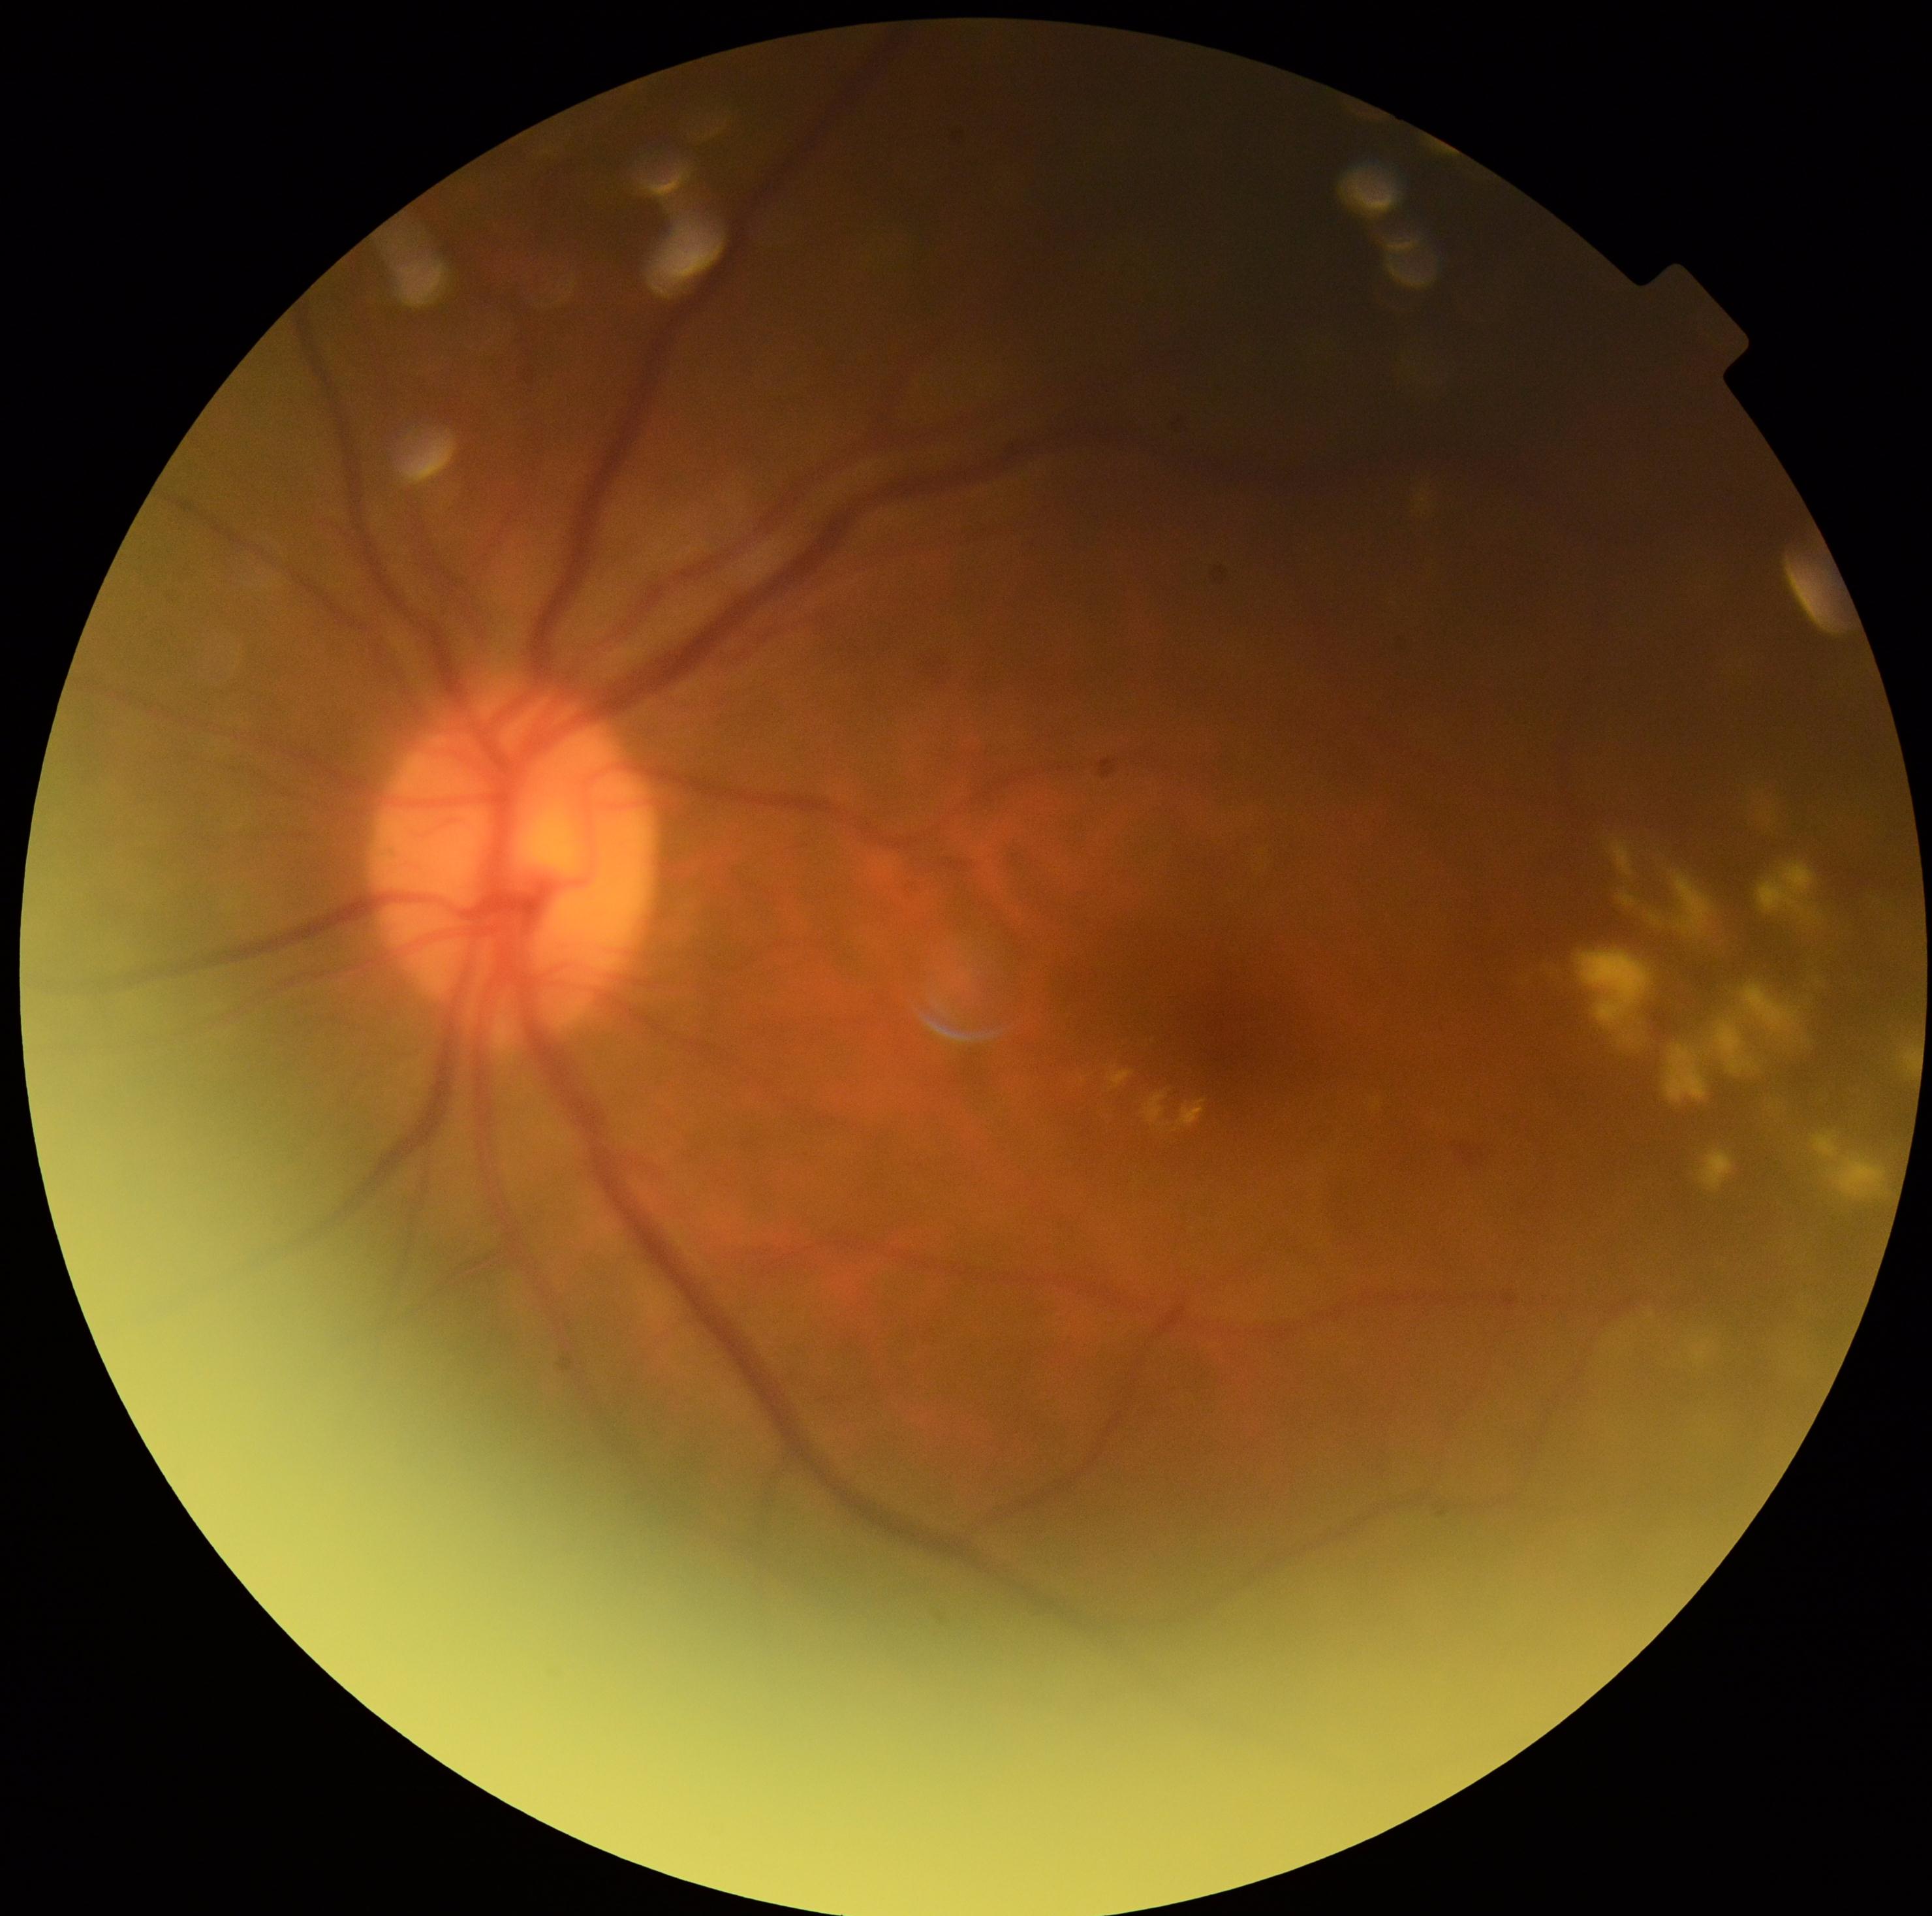 Retinopathy grade: 2.